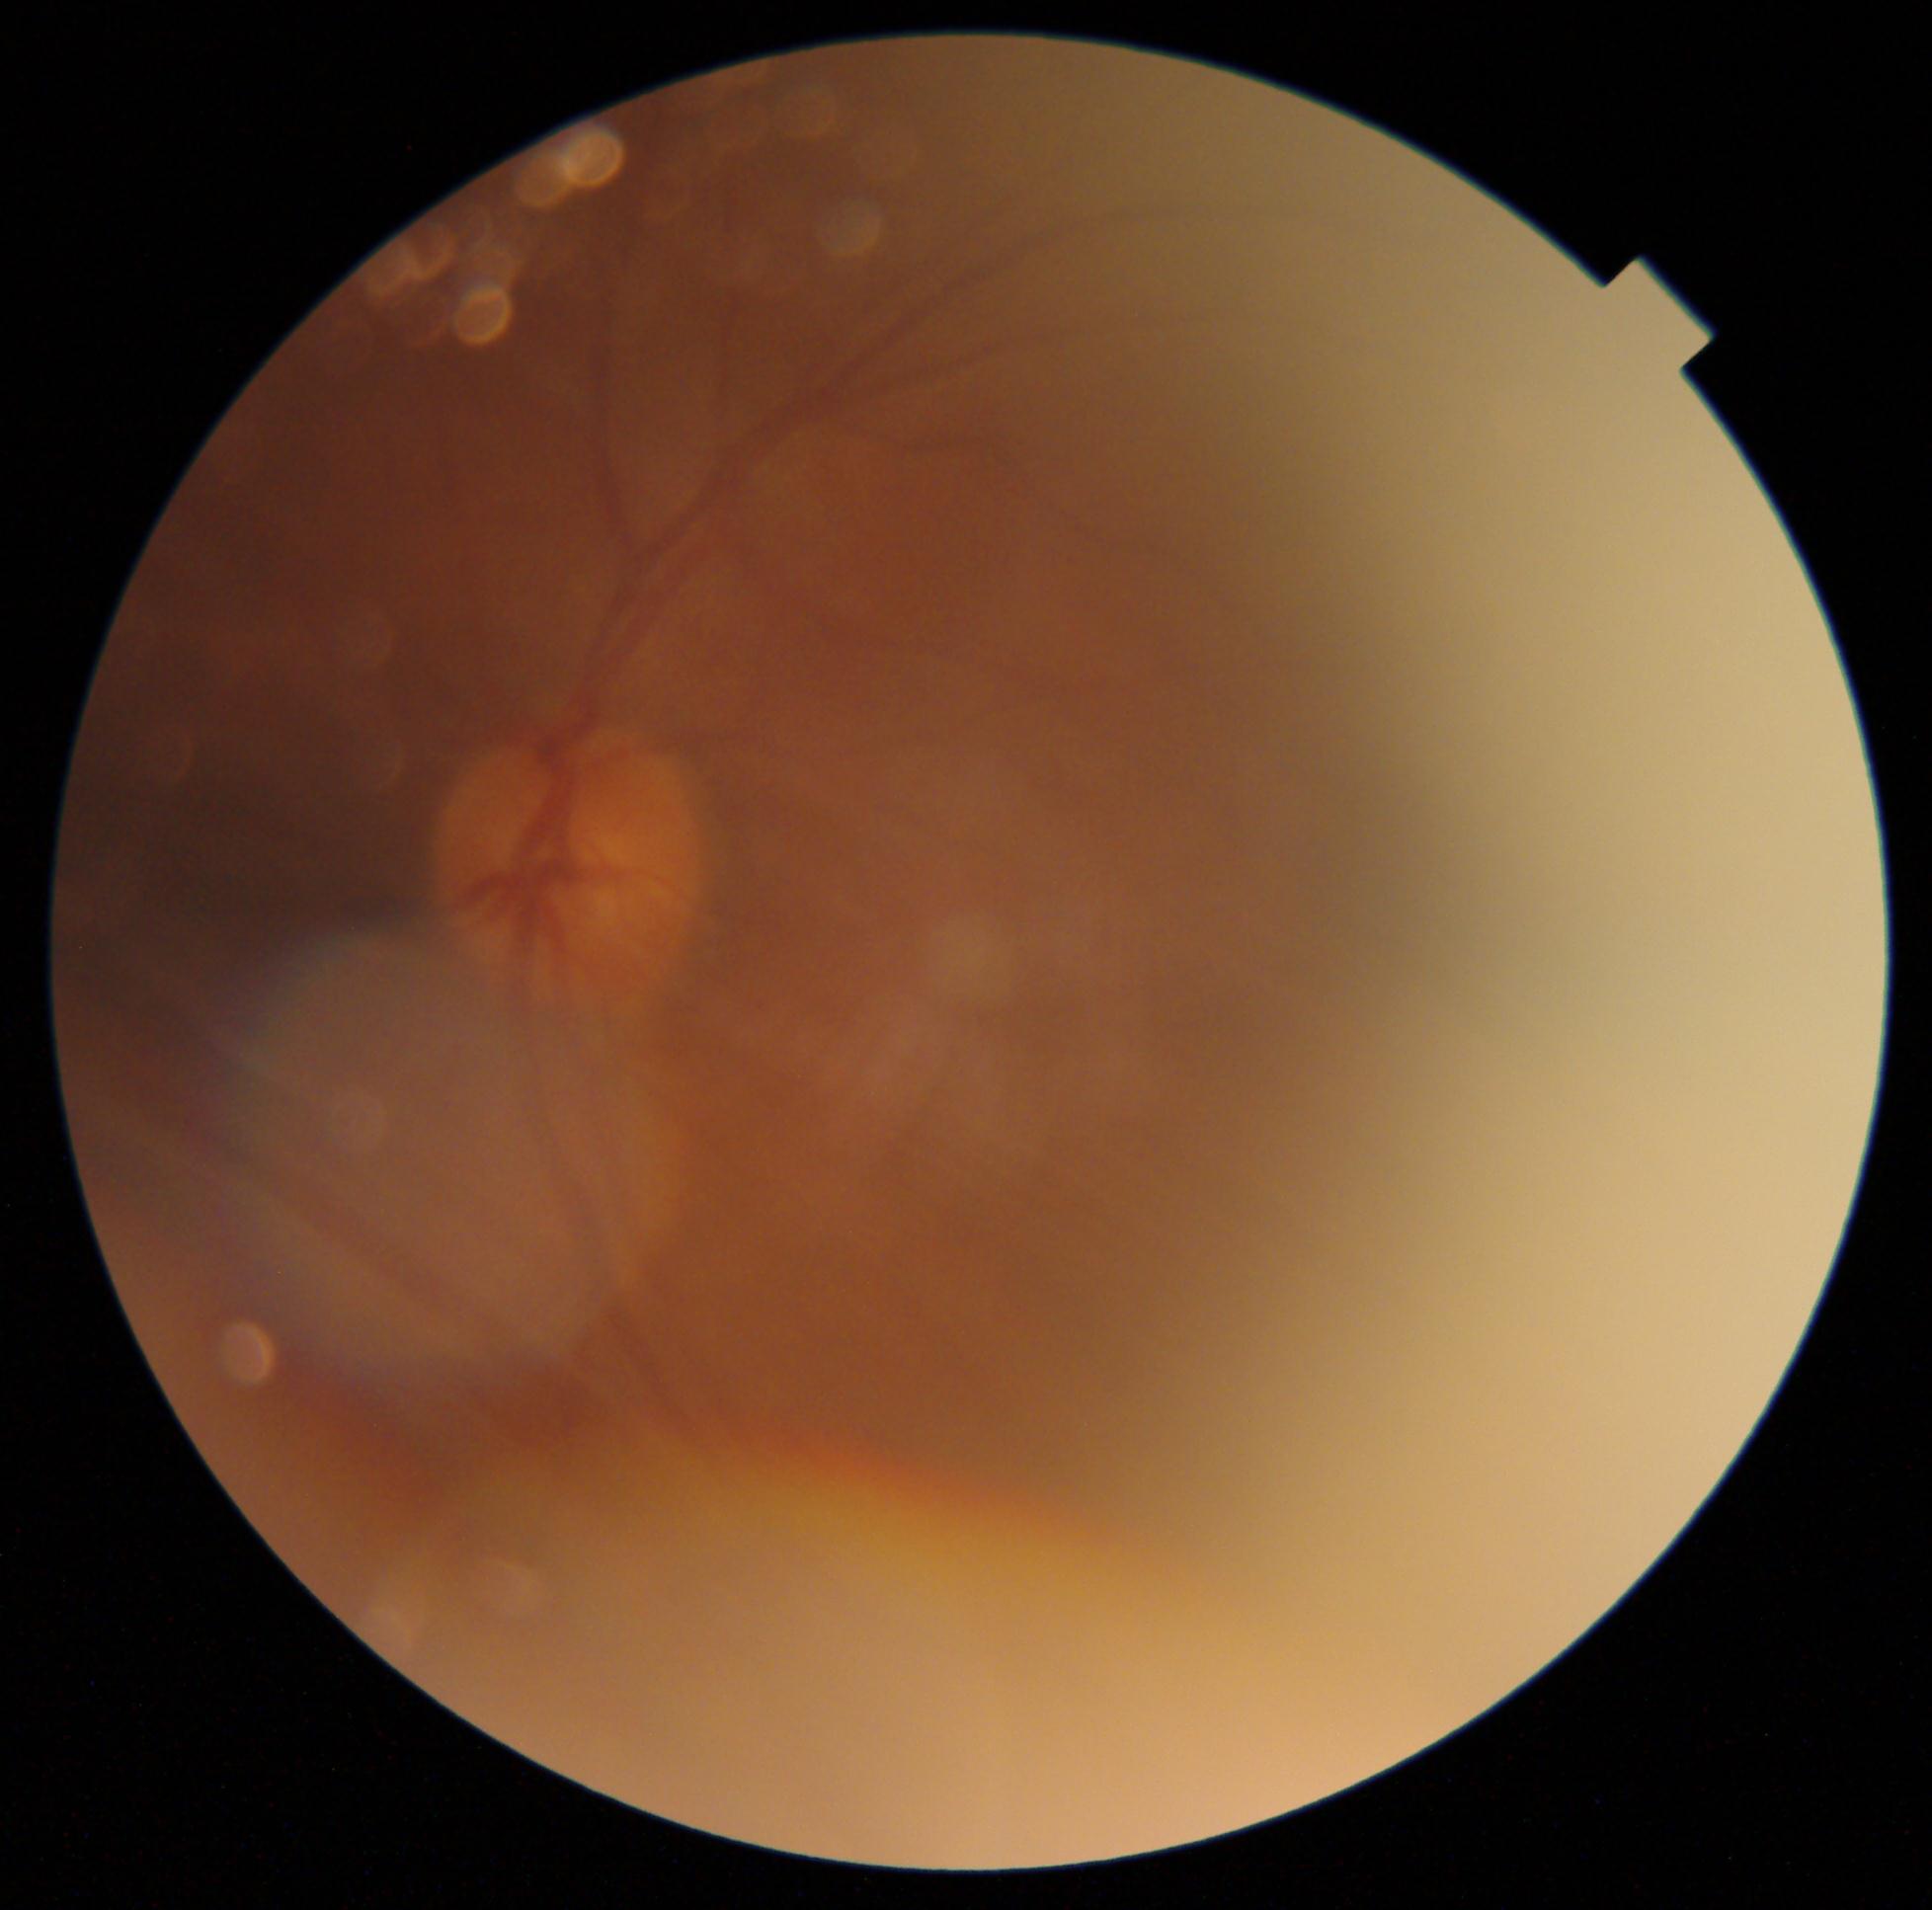
Retinopathy is ungradable.
Image quality is insufficient for diabetic retinopathy assessment.